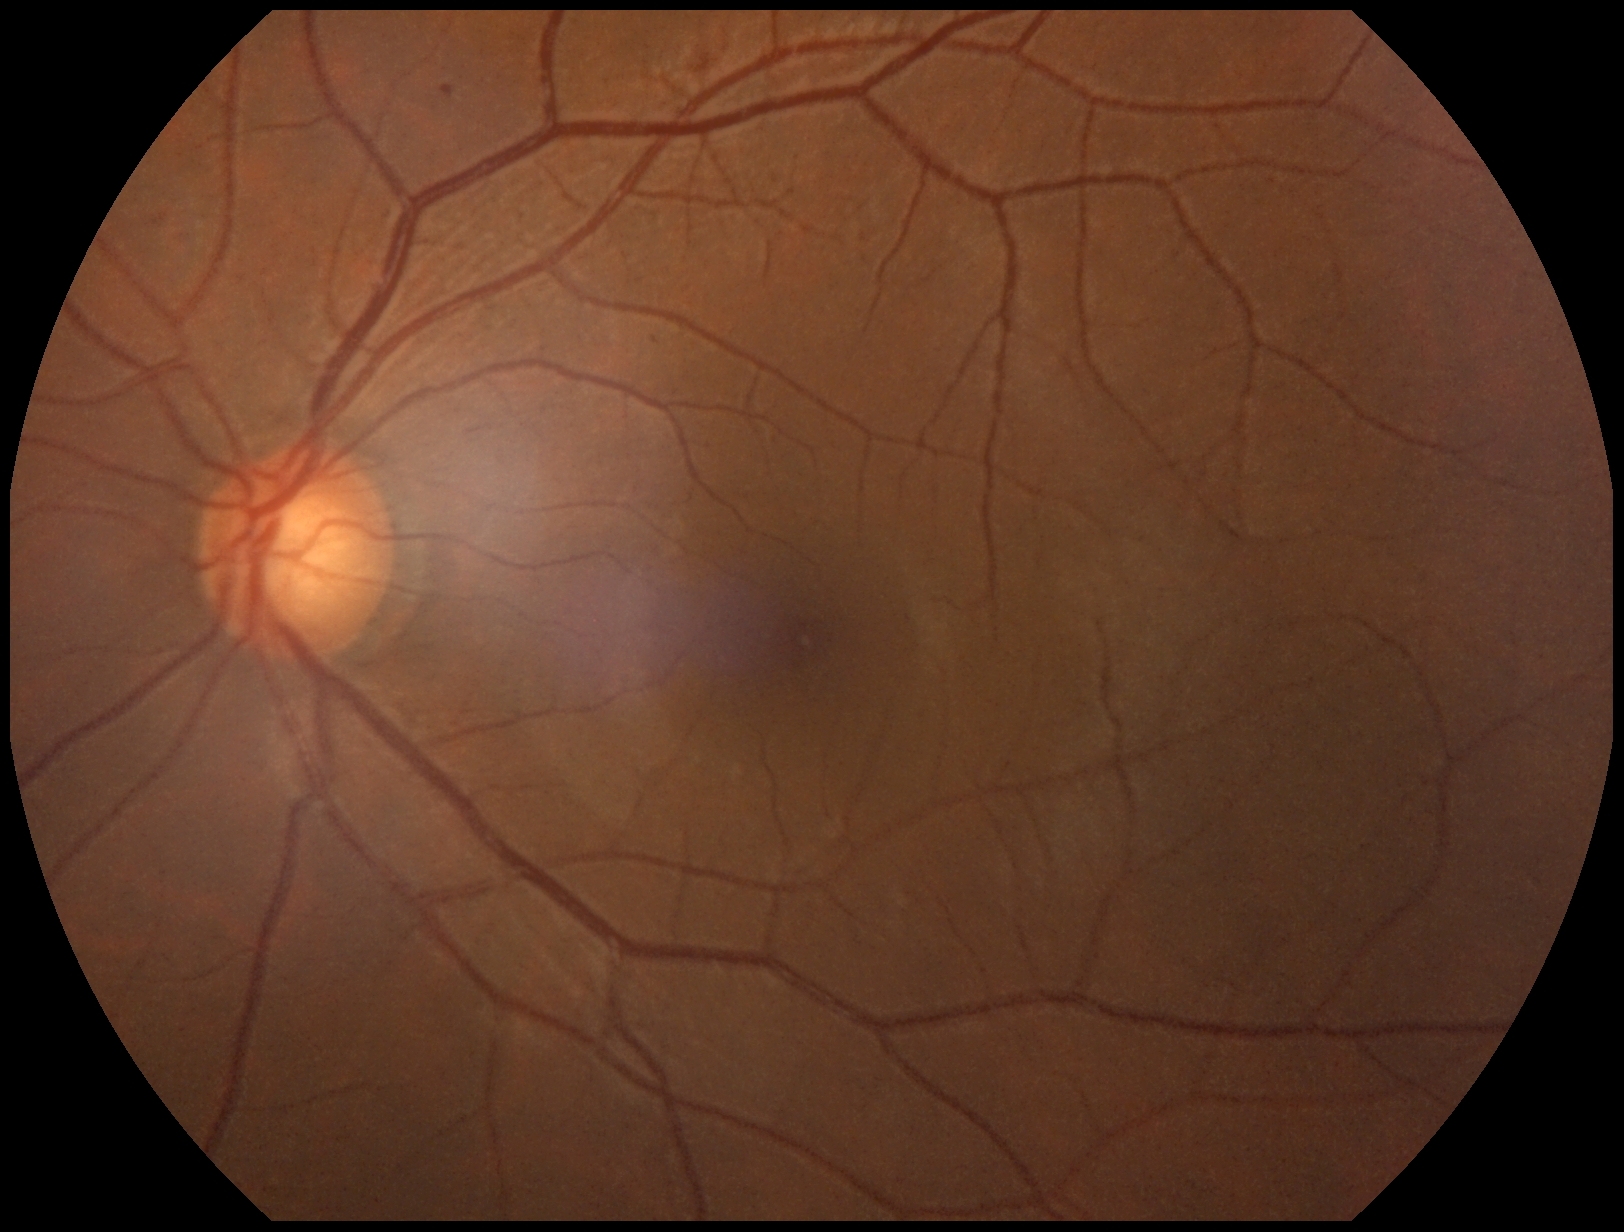 diabetic retinopathy grade@2; DR class@non-proliferative diabetic retinopathy.